Infant wide-field fundus photograph · 1240 by 1240 pixels.
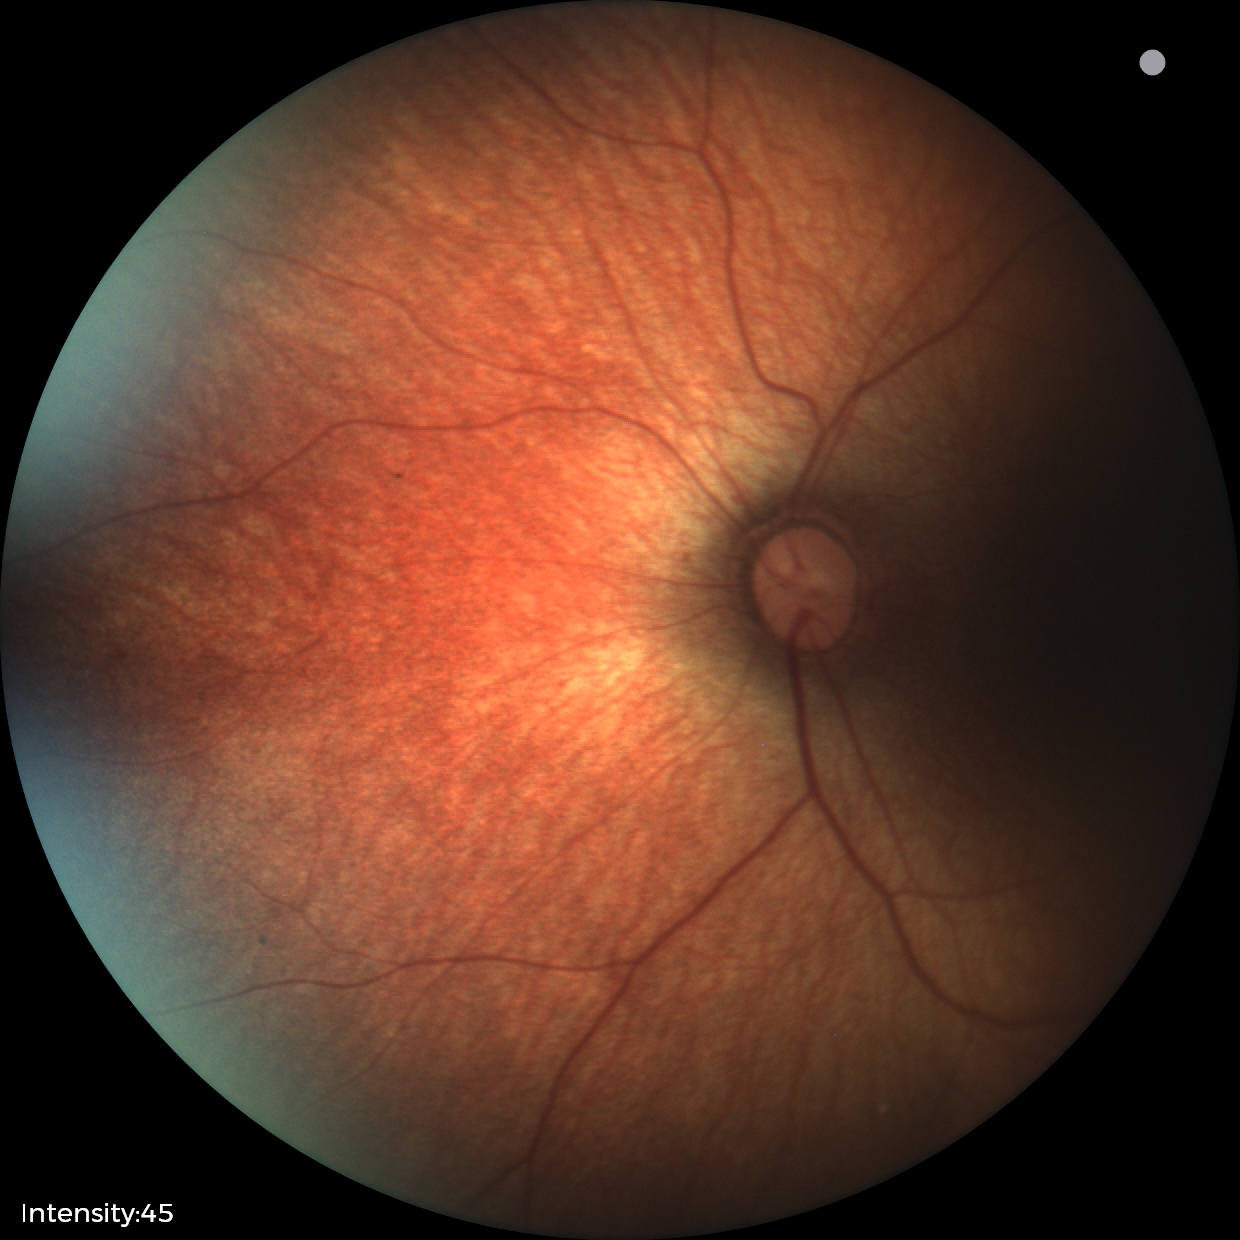 Screening examination with no abnormal retinal findings.